Retinal fundus photograph · 1960 by 1897 pixels — 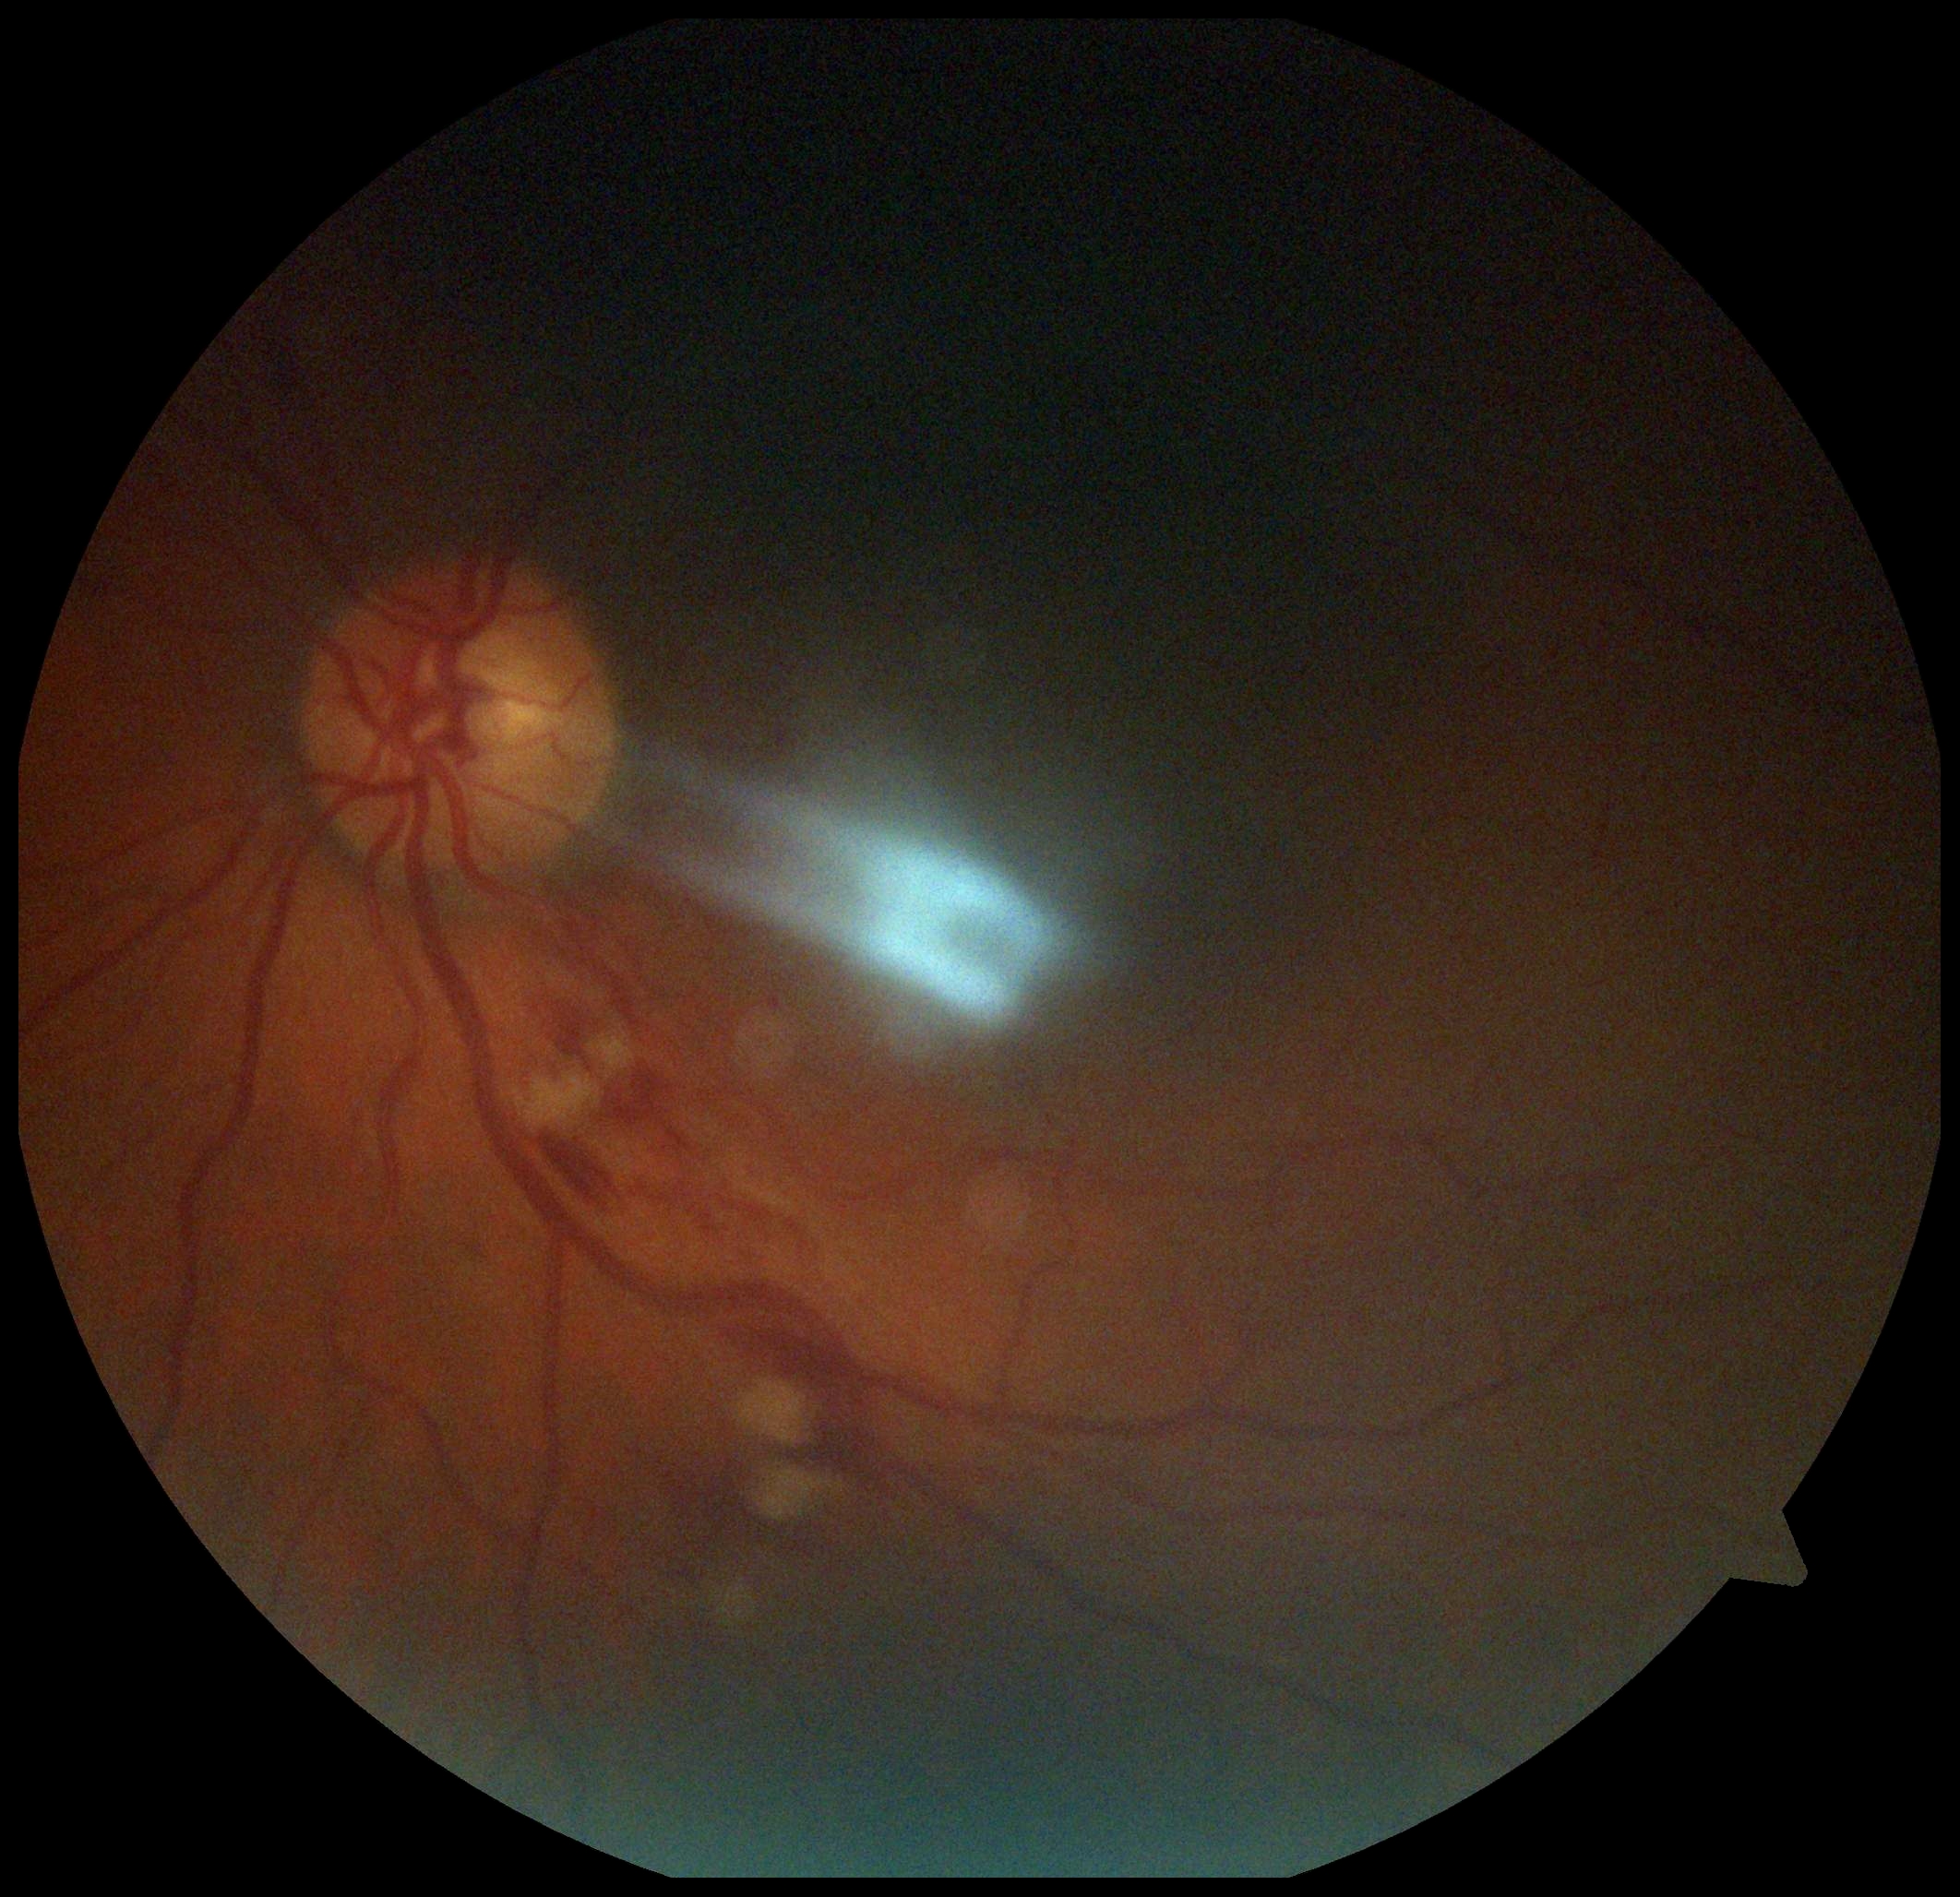   dr_category: non-proliferative diabetic retinopathy
  dr_grade: 2 — more than just microaneurysms but less than severe NPDR